No pharmacologic dilation. 45 degree fundus photograph — 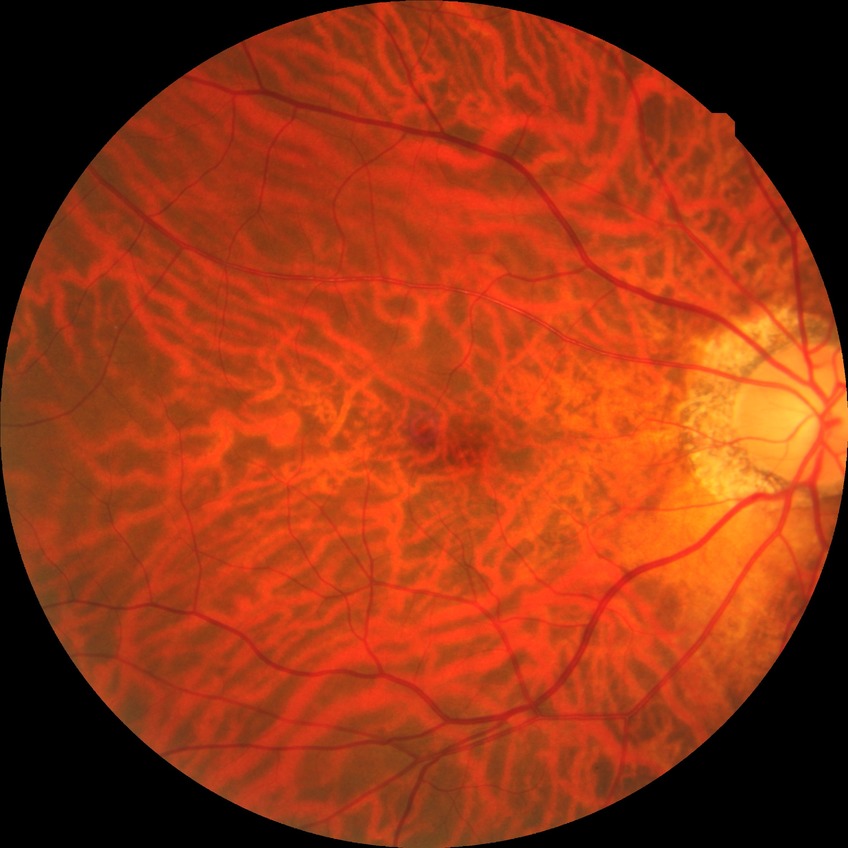 DR severity is NDR.